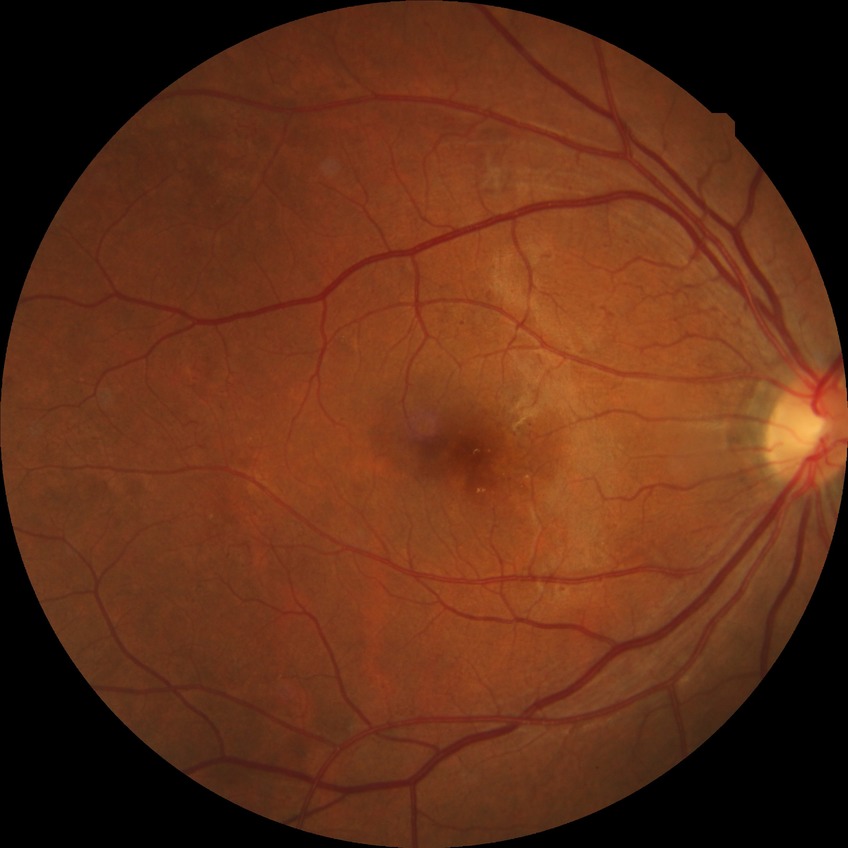

Diabetic retinopathy (DR): PDR (proliferative diabetic retinopathy).